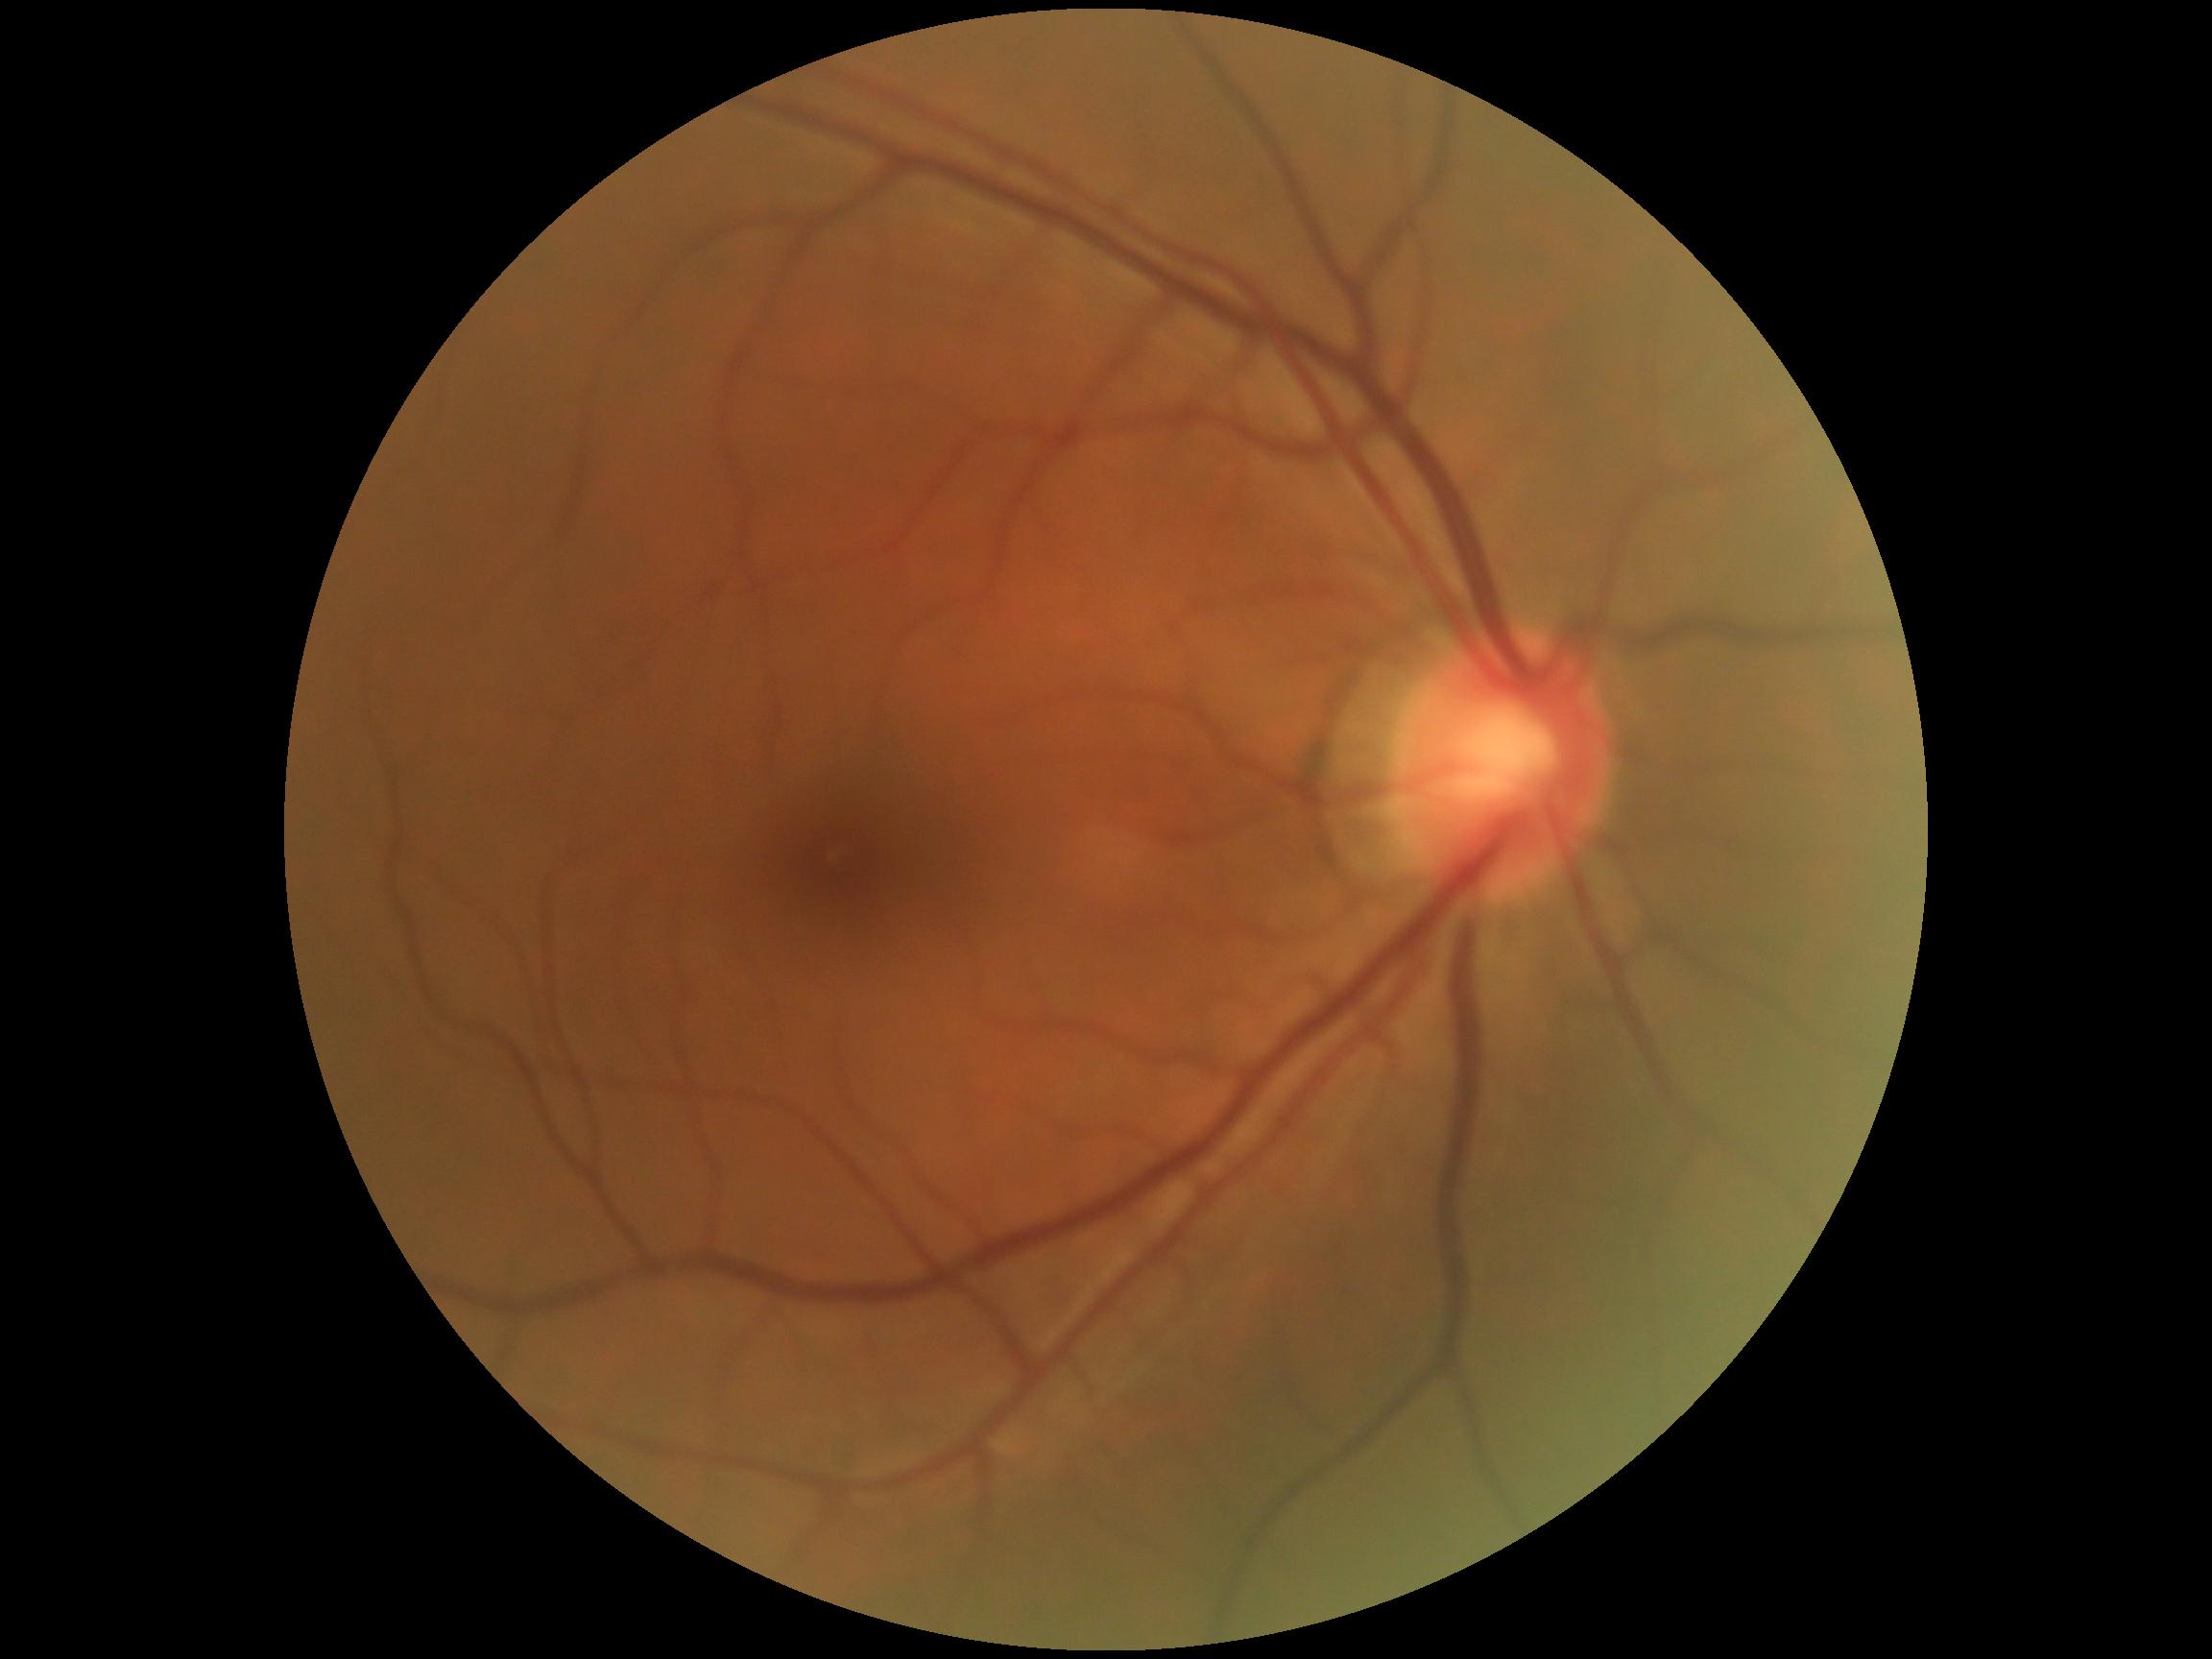

No apparent diabetic retinopathy. DR stage is no apparent diabetic retinopathy (grade 0).